NIDEK AFC-230, 848x848px, 45° field of view, nonmydriatic fundus photograph, posterior pole color fundus photograph.
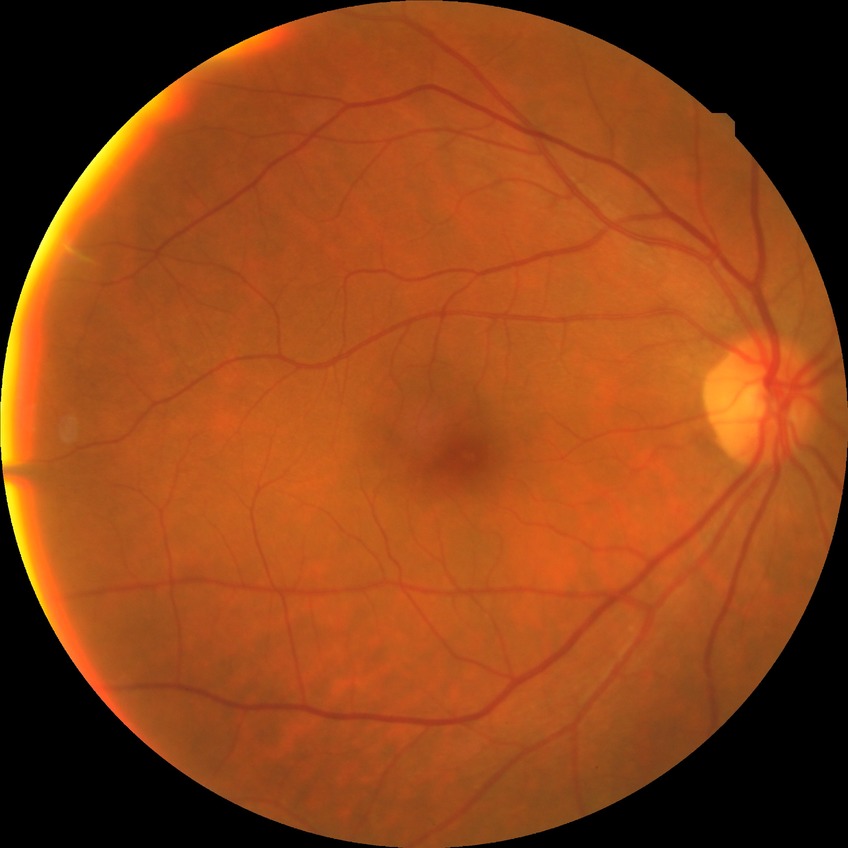 retinopathy grade: no diabetic retinopathy.